NIDEK AFC-230 fundus camera, 45° FOV, nonmydriatic fundus photograph, modified Davis classification, retinal fundus photograph:
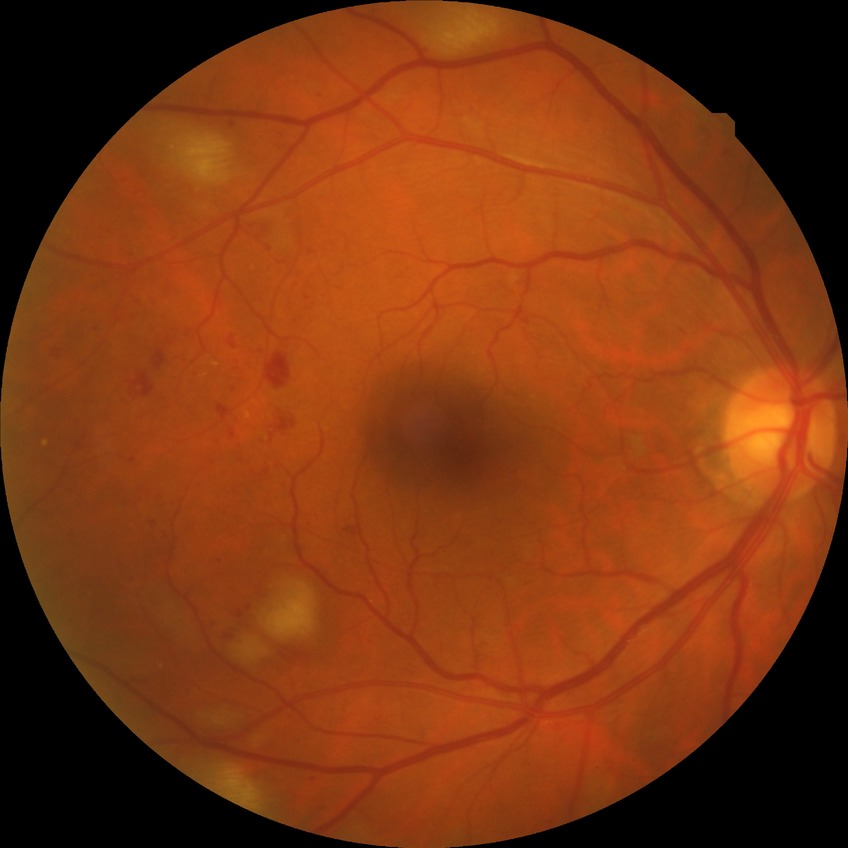
  davis_grade: PPDR (pre-proliferative diabetic retinopathy)